2352 by 1568 pixels — 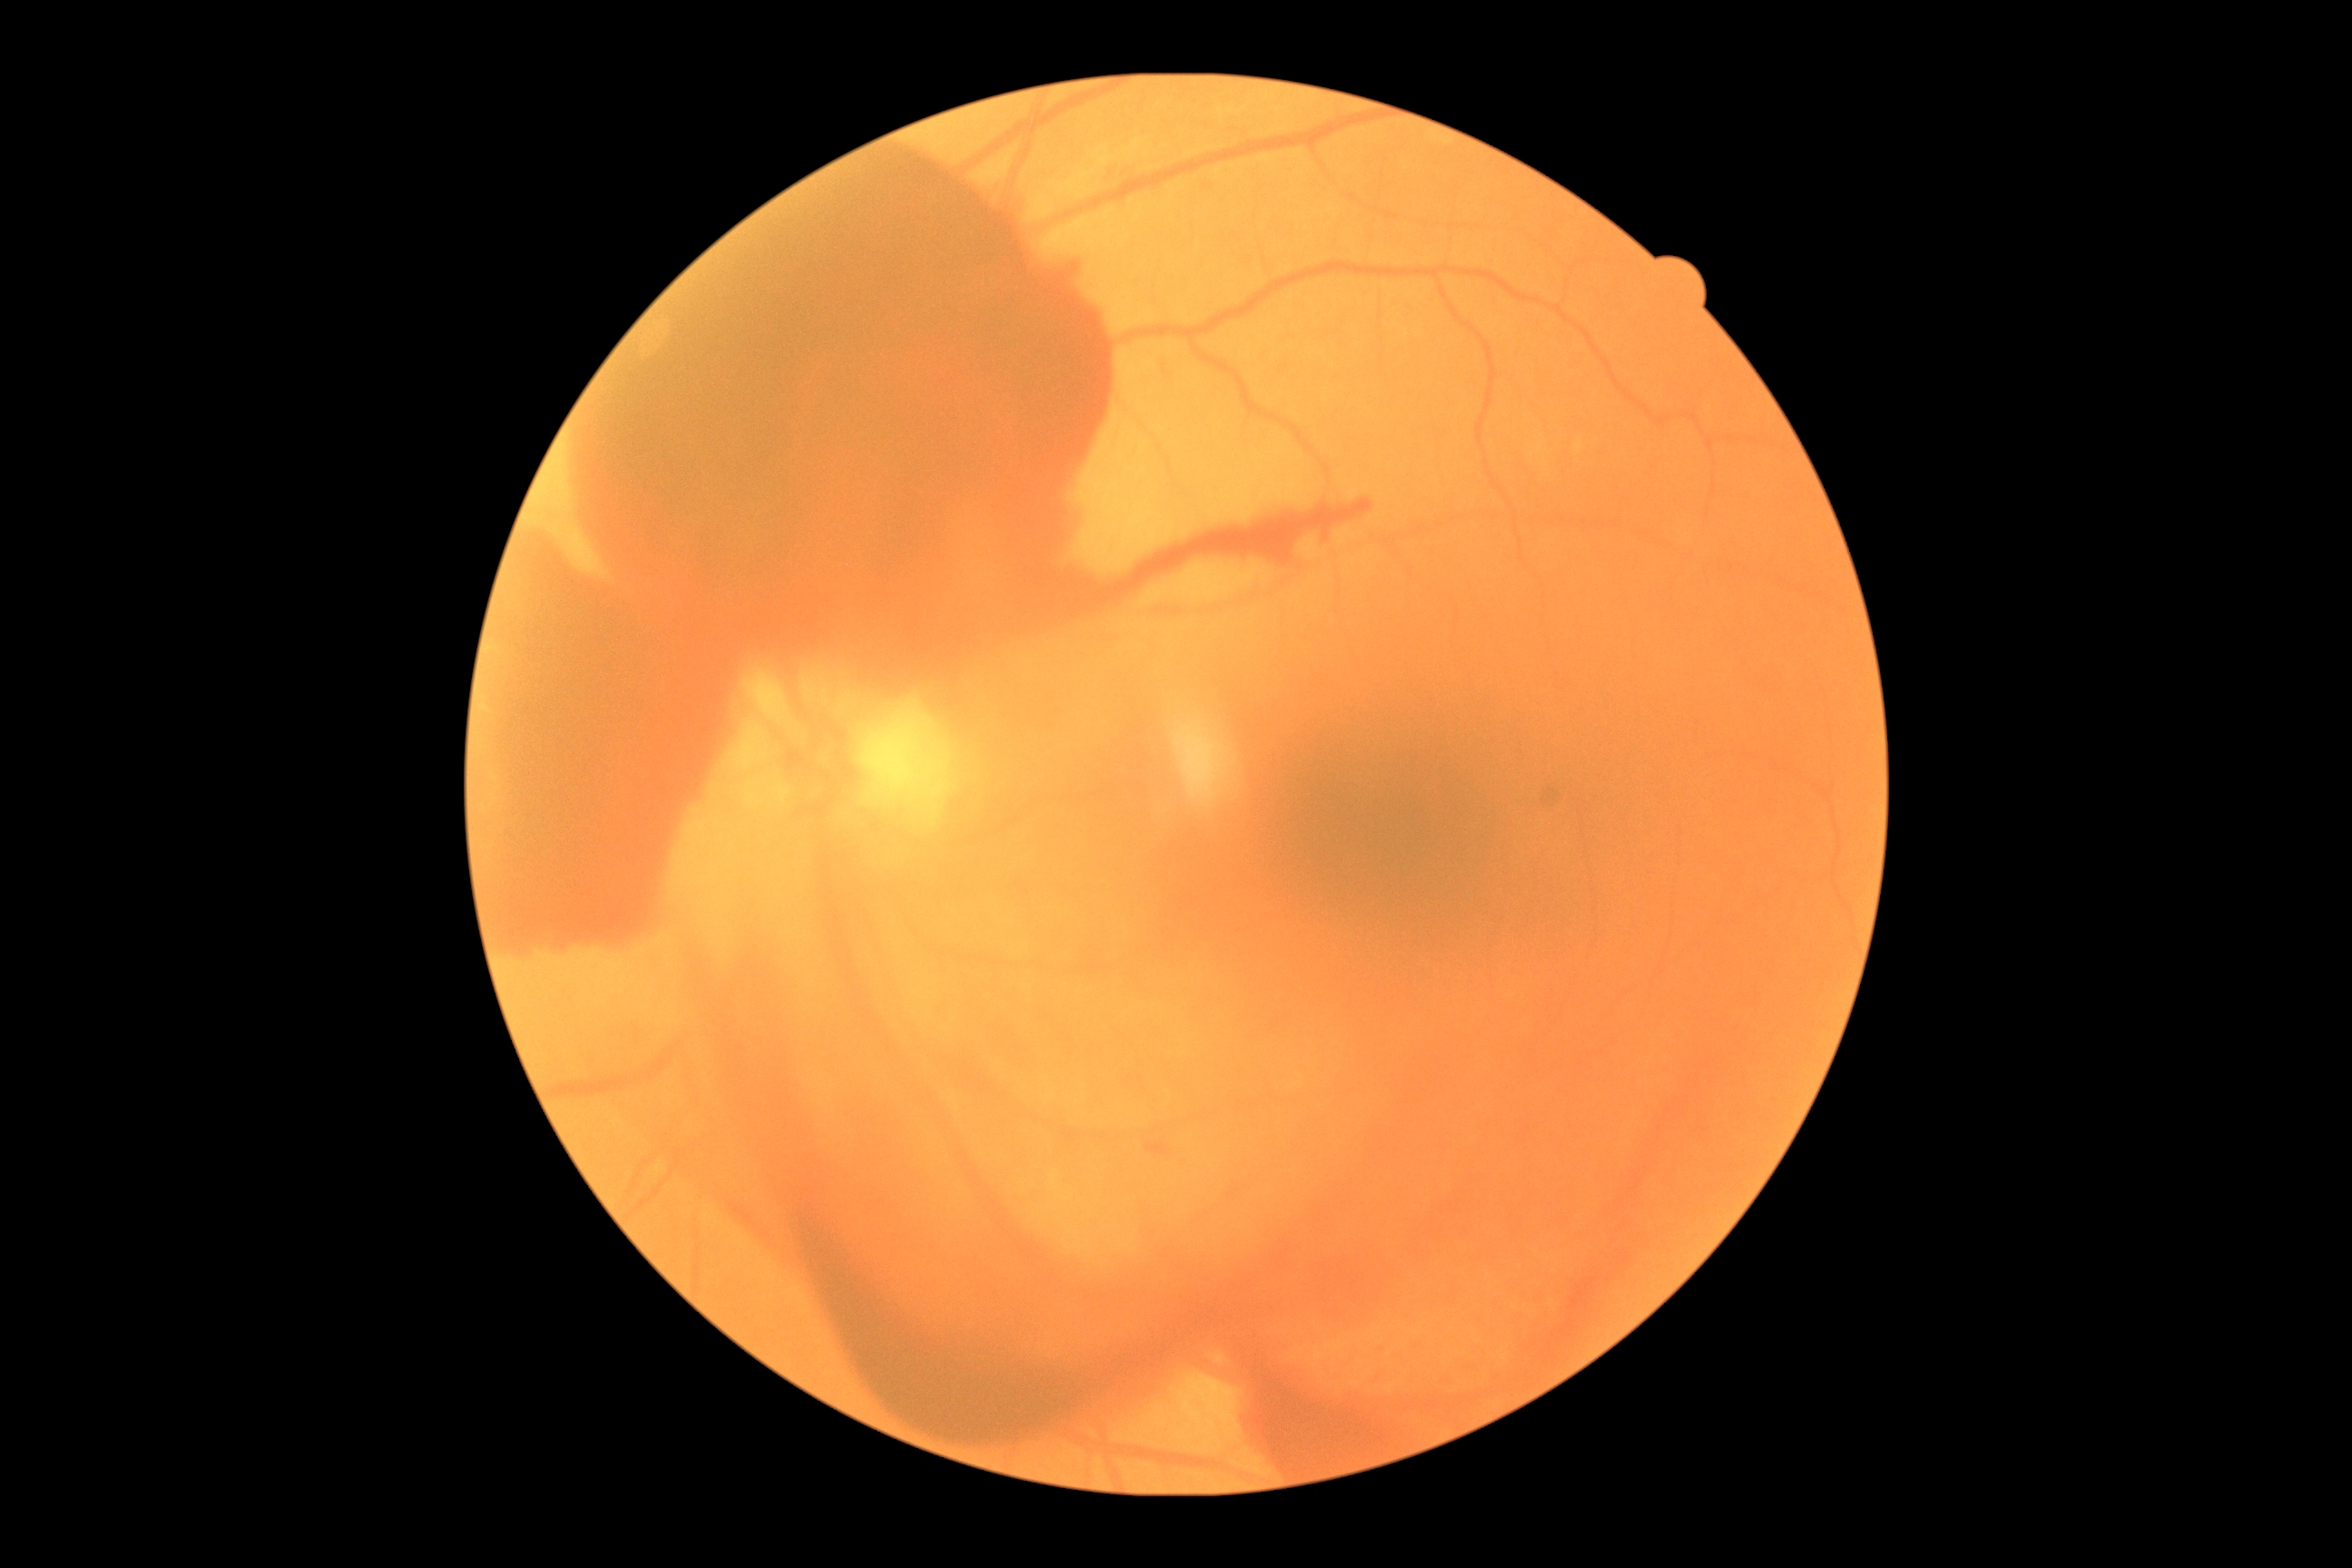
DR class: proliferative diabetic retinopathy; DR stage: proliferative diabetic retinopathy (grade 4).